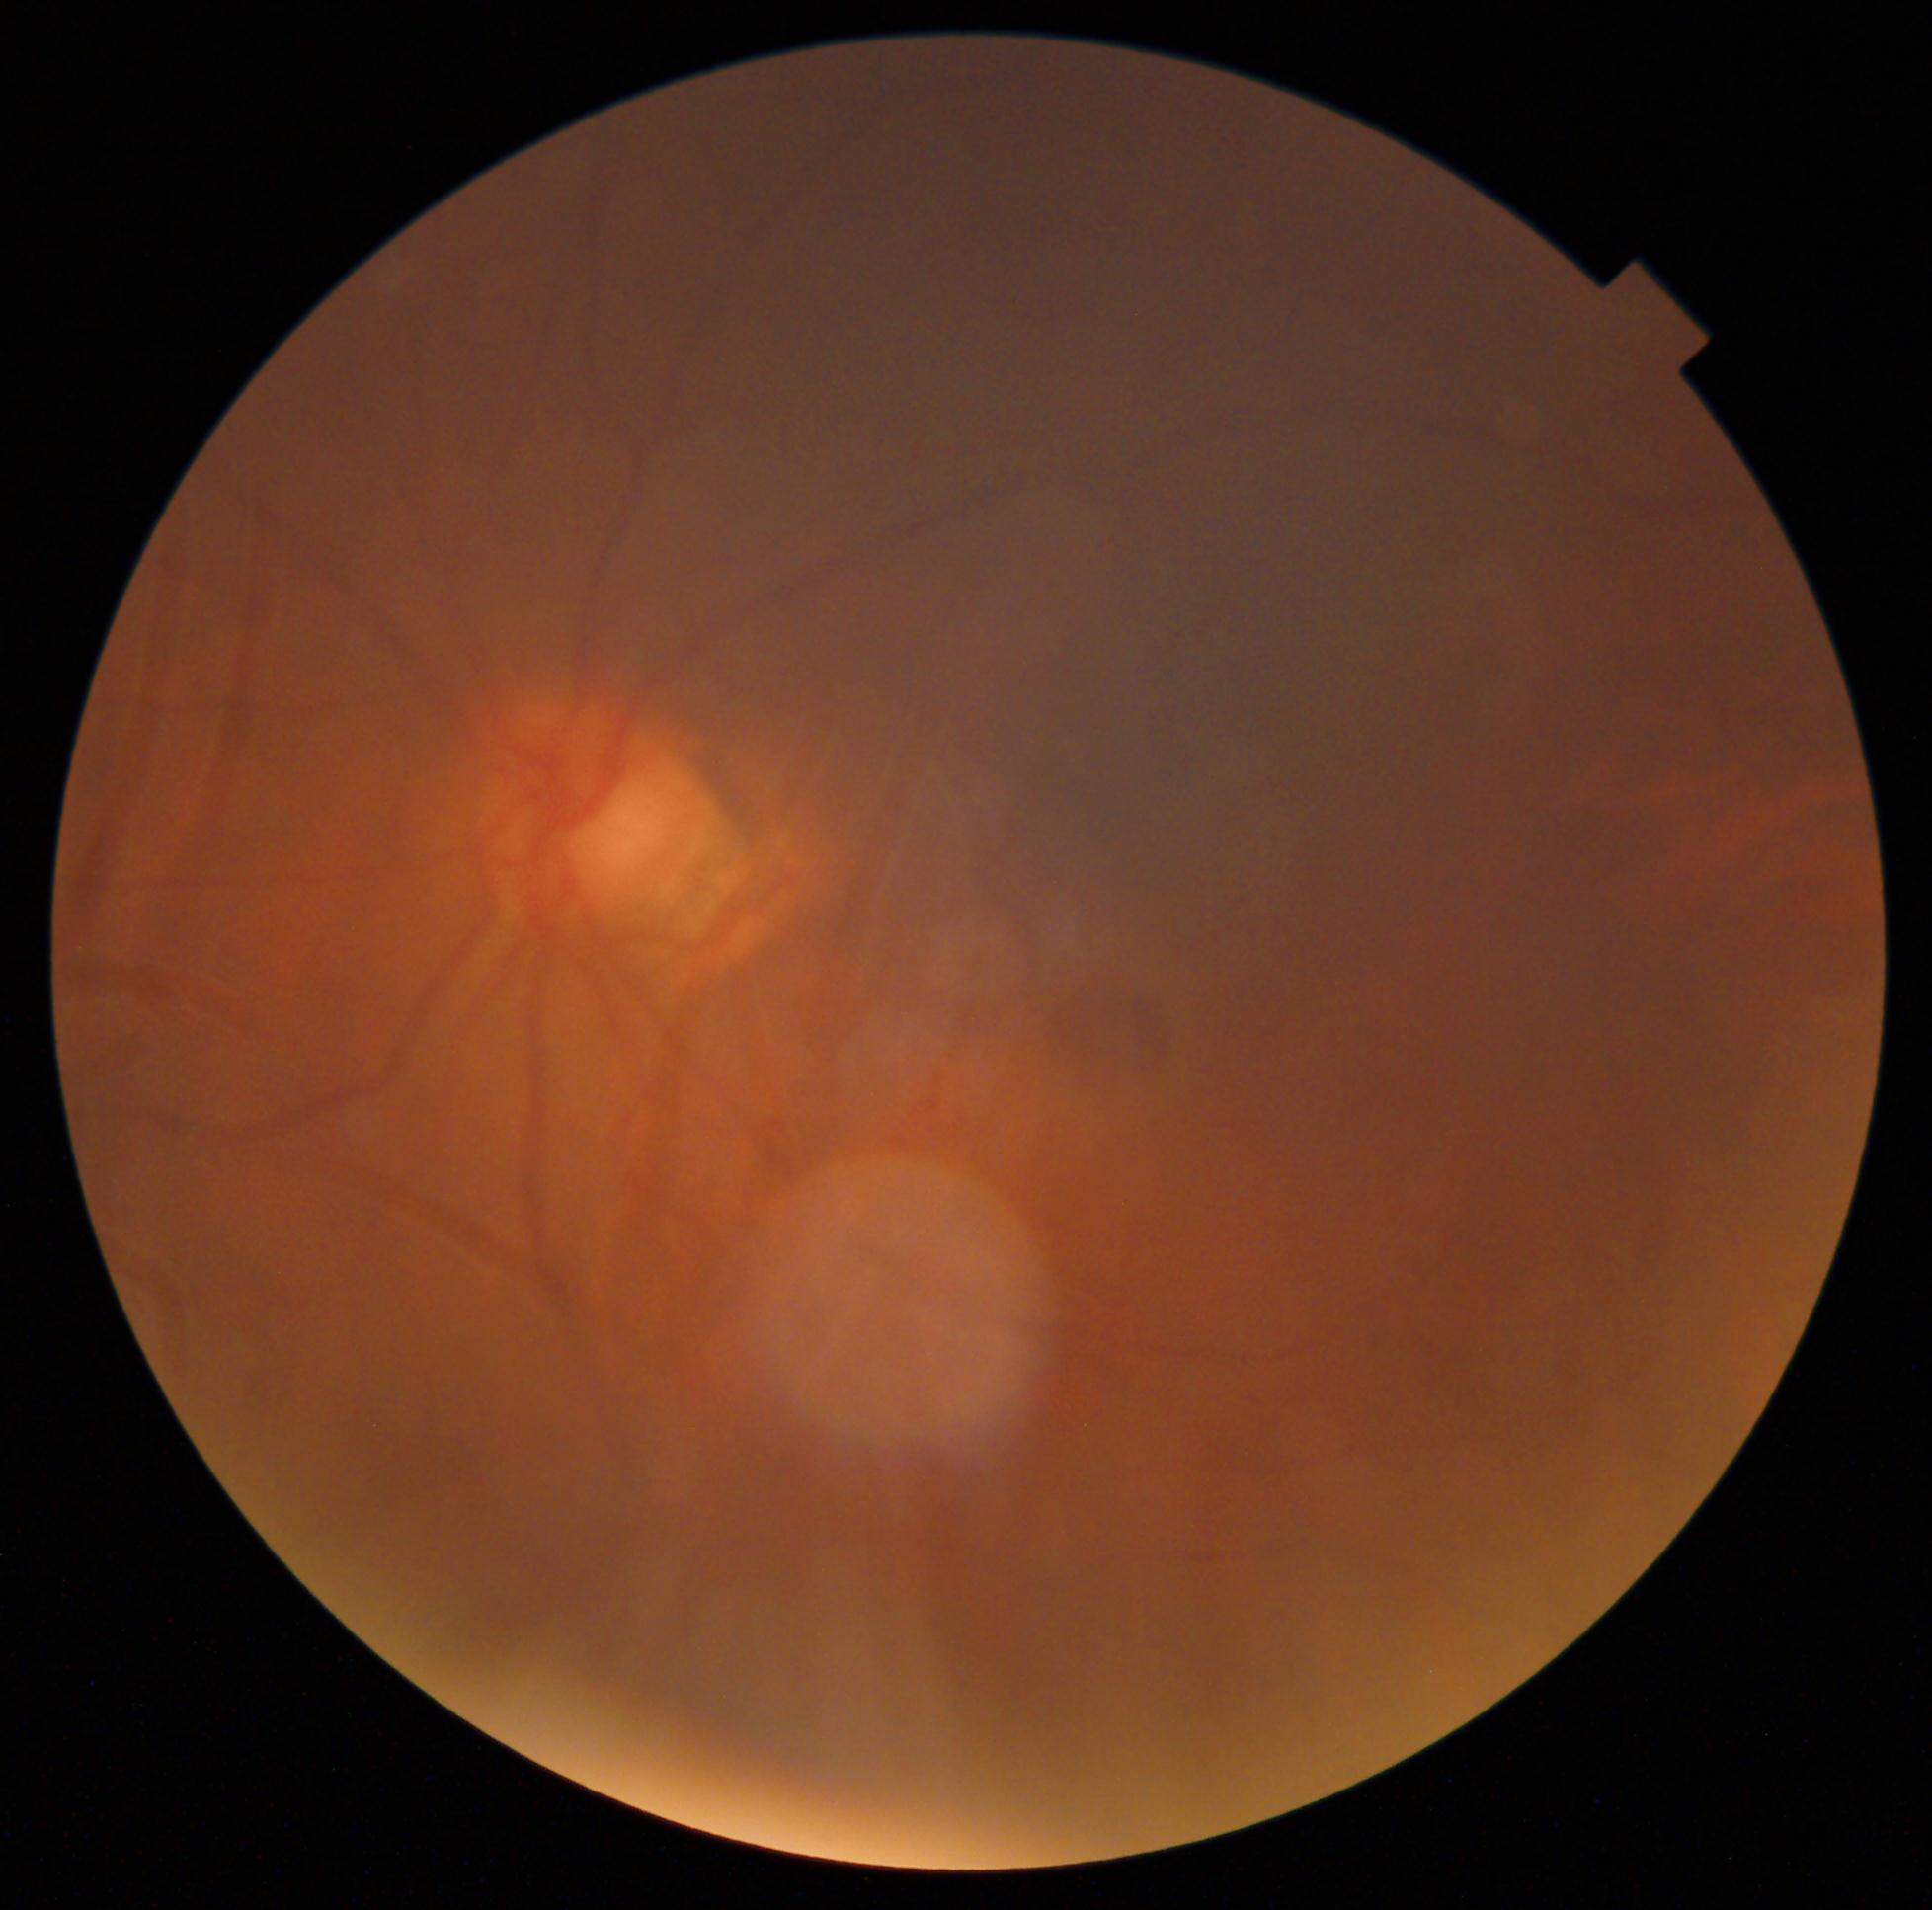 Annotations:
• DR impression — no DR findings
• DR grade — no apparent diabetic retinopathy (0)